1240 x 1240 pixels. Pediatric wide-field fundus photograph.
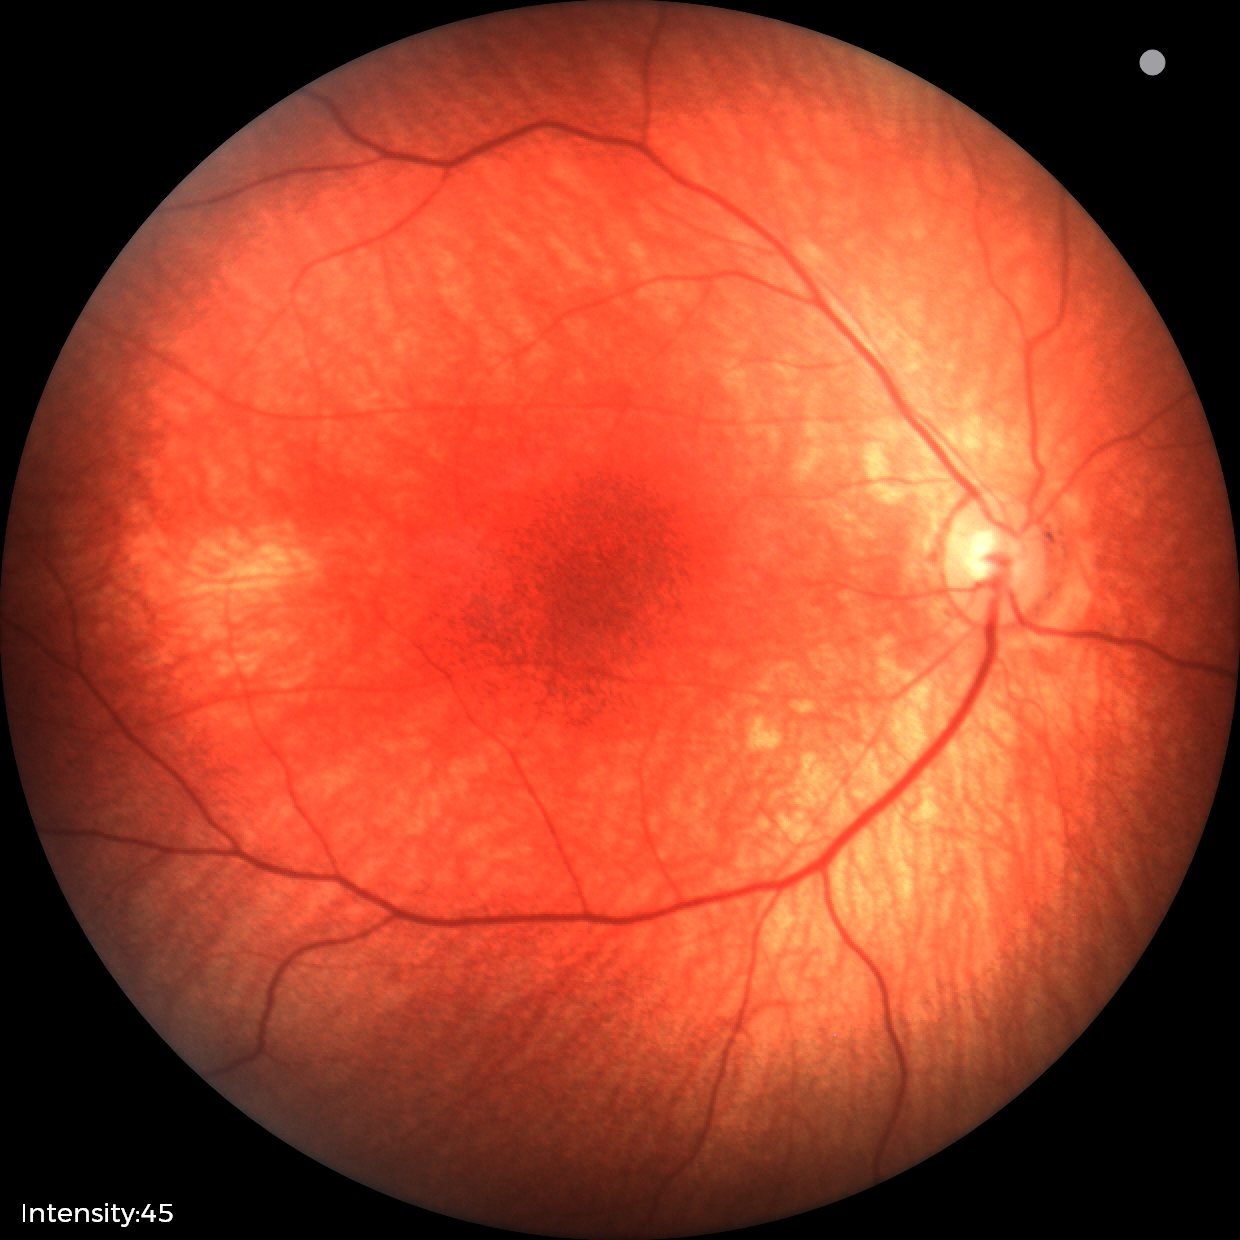 Assessment: normal.